45-degree field of view; retinal fundus photograph; 412x310px:
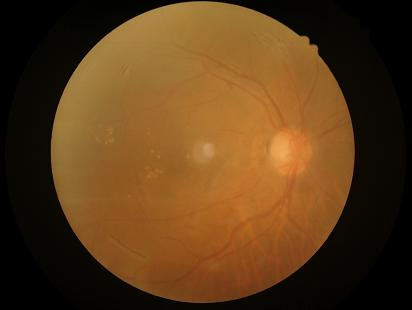

Noticeable blur in the optic disc, vessels, or background.
Image quality is inadequate for diagnostic use.
Narrow intensity range; structures are hard to distinguish.
Illumination is even.